2048 x 1536 pixels:
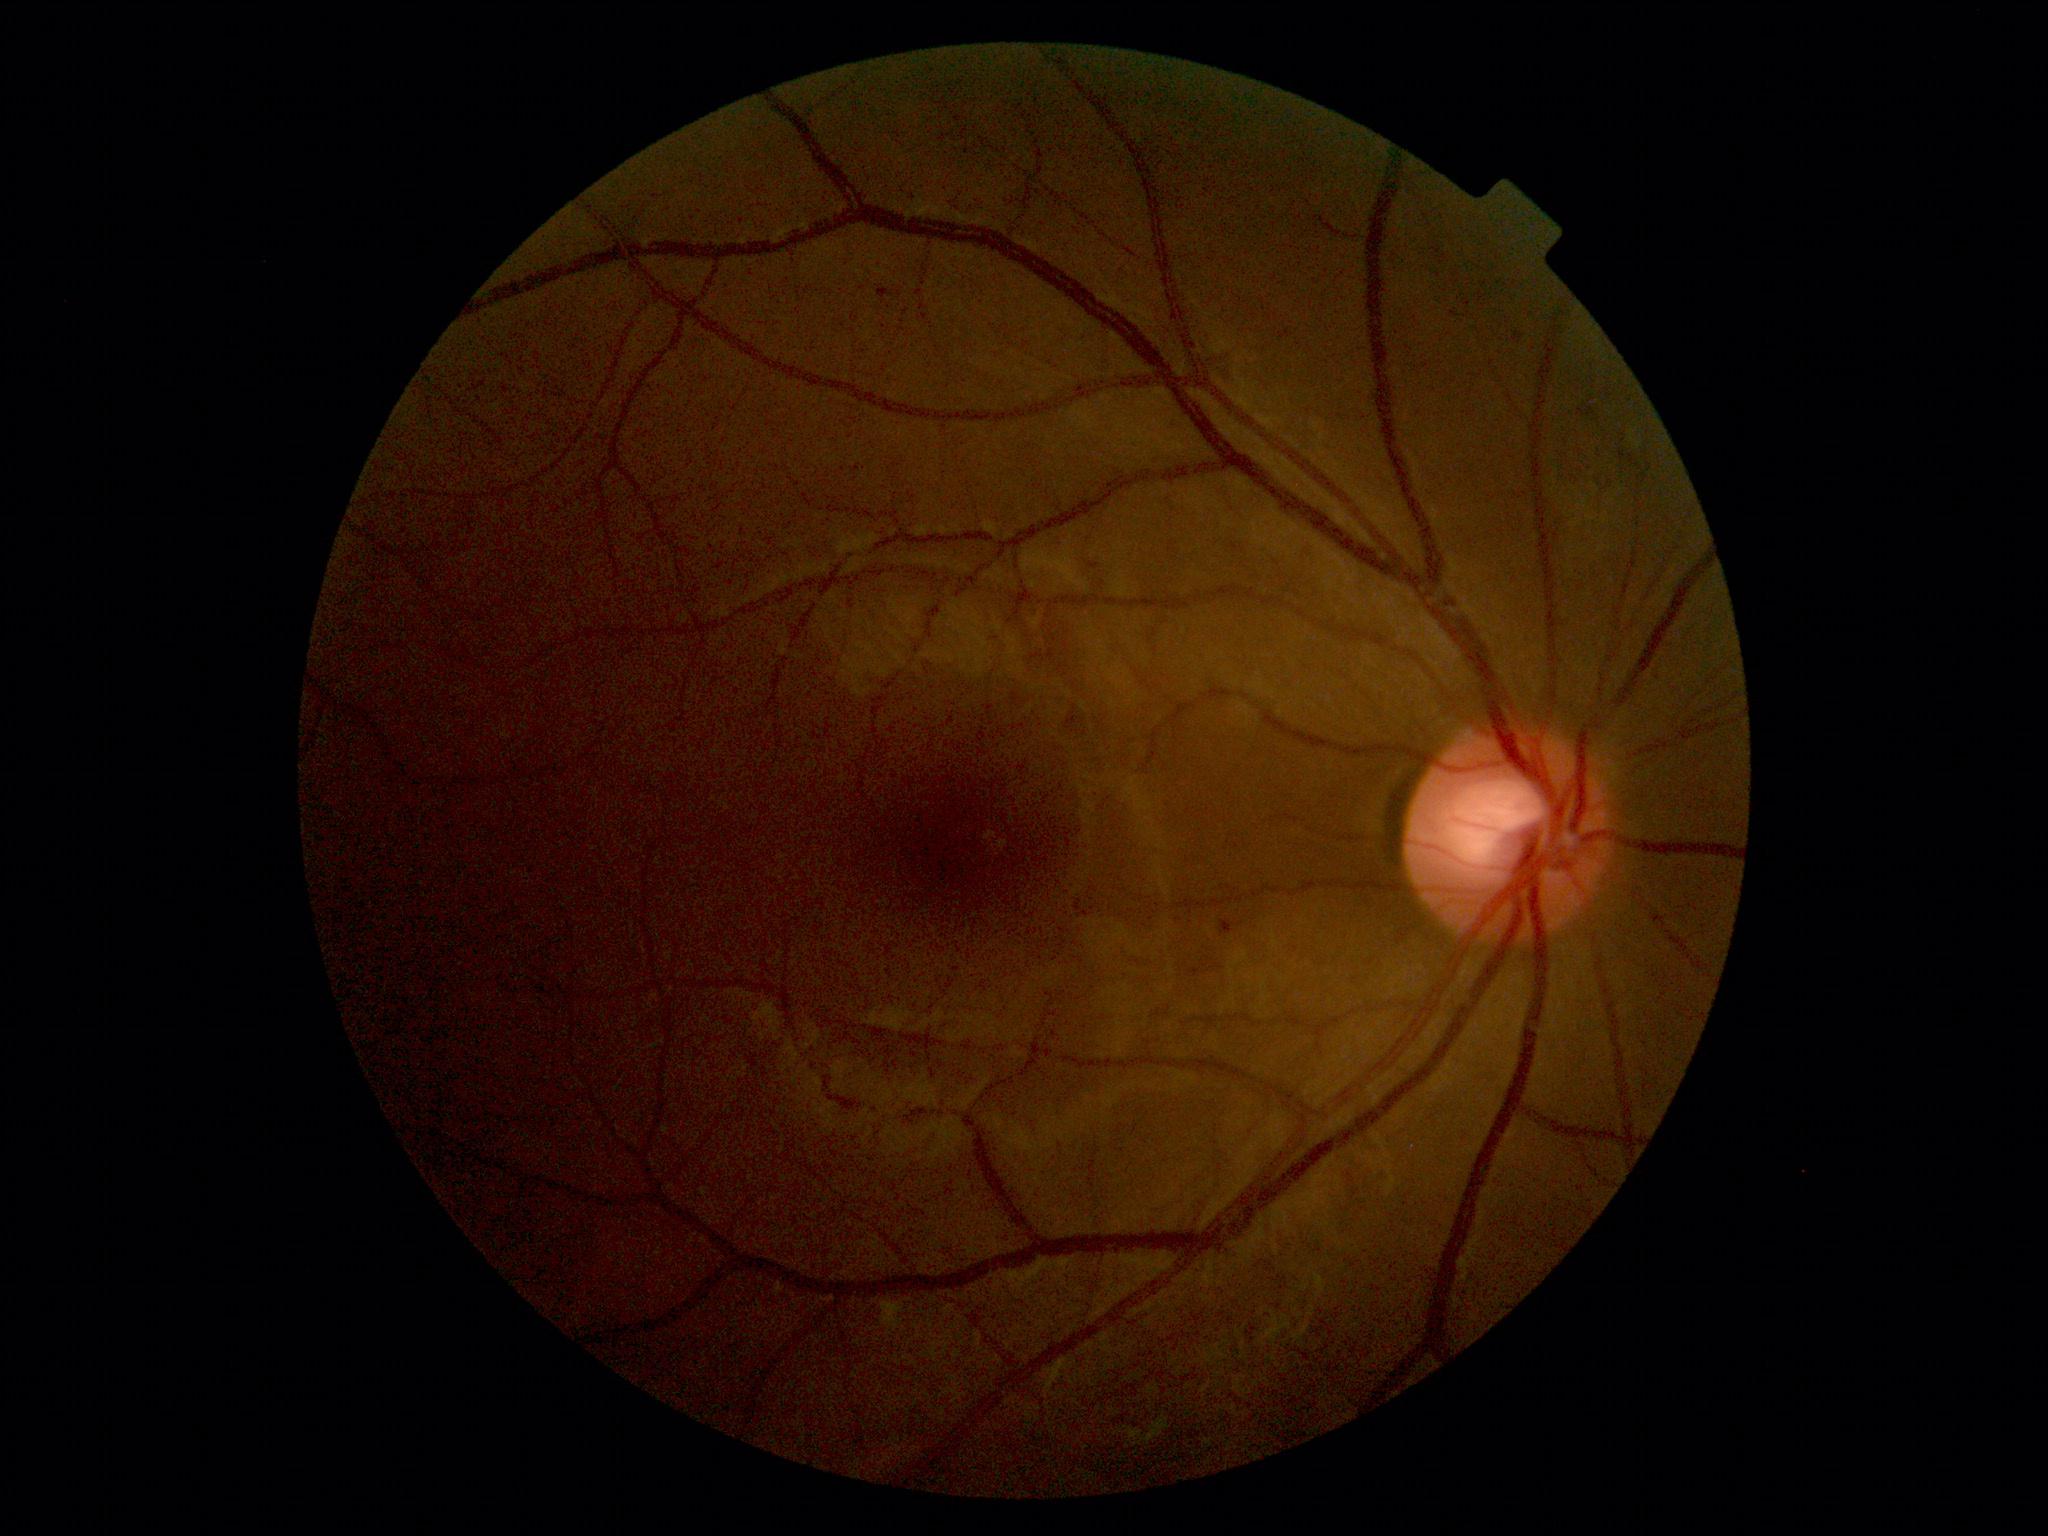 dr_grade: 1
dr_grade_name: mild NPDR
lesions:
  se: []
  he: []
  ex: []
  ma:
    - 1451:312:1460:318
    - 877:287:893:299
    - 1513:332:1524:342
    - 1220:919:1235:935
  ma_small_centers:
    - x=885 y=327